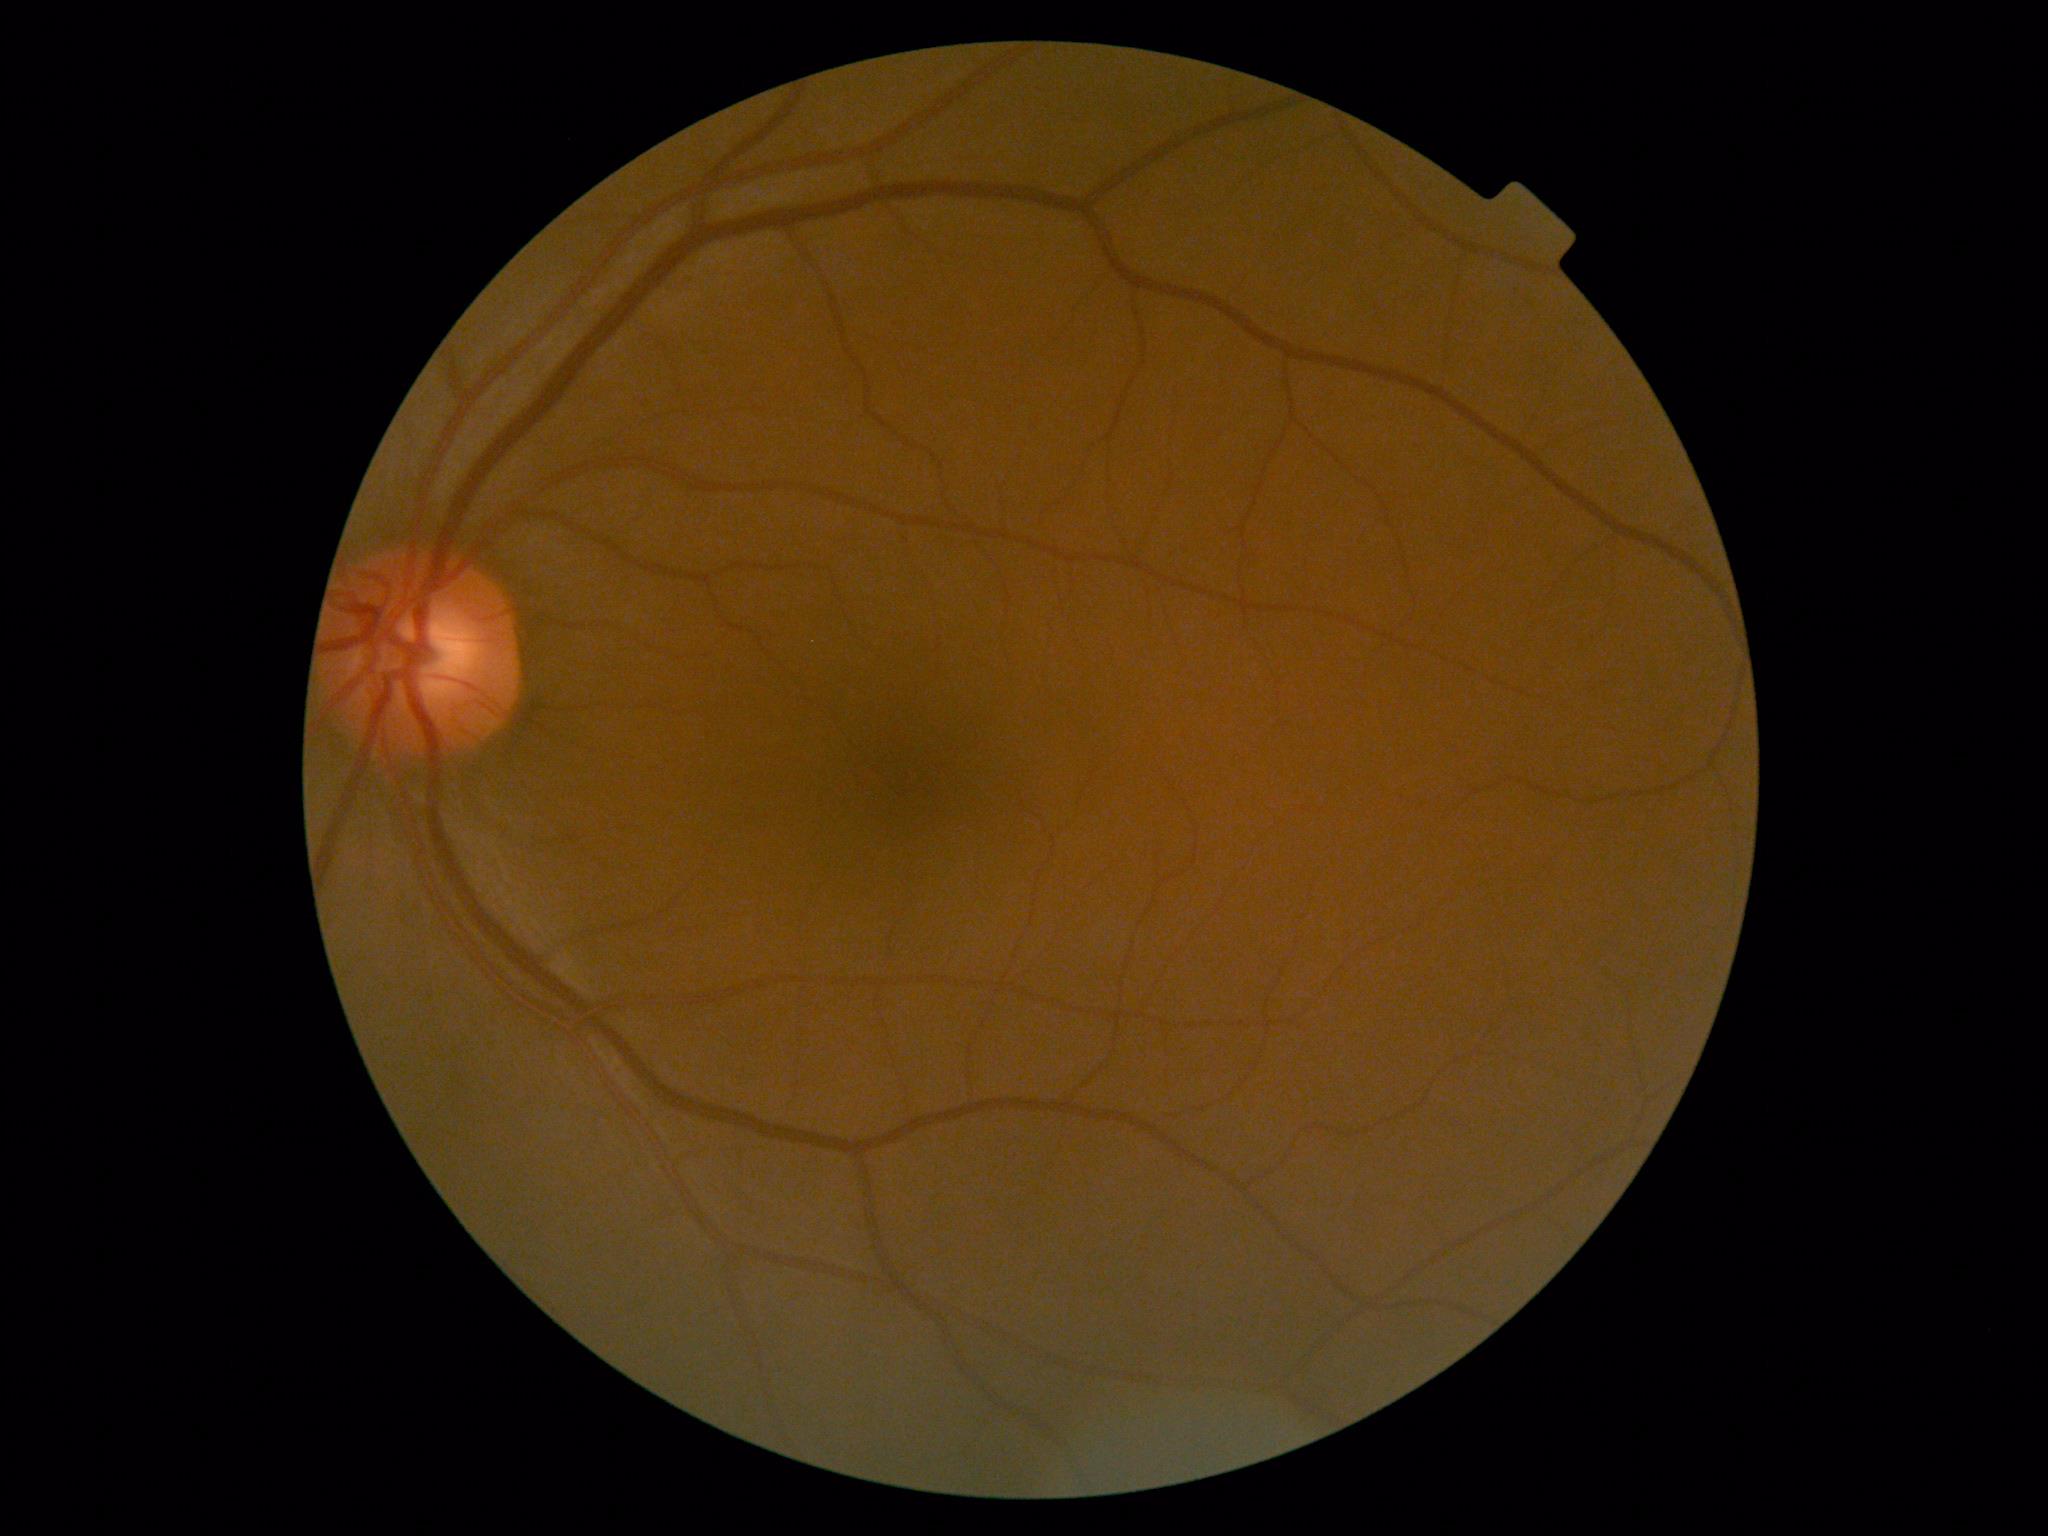 DR = 0, DR impression = no DR findings.